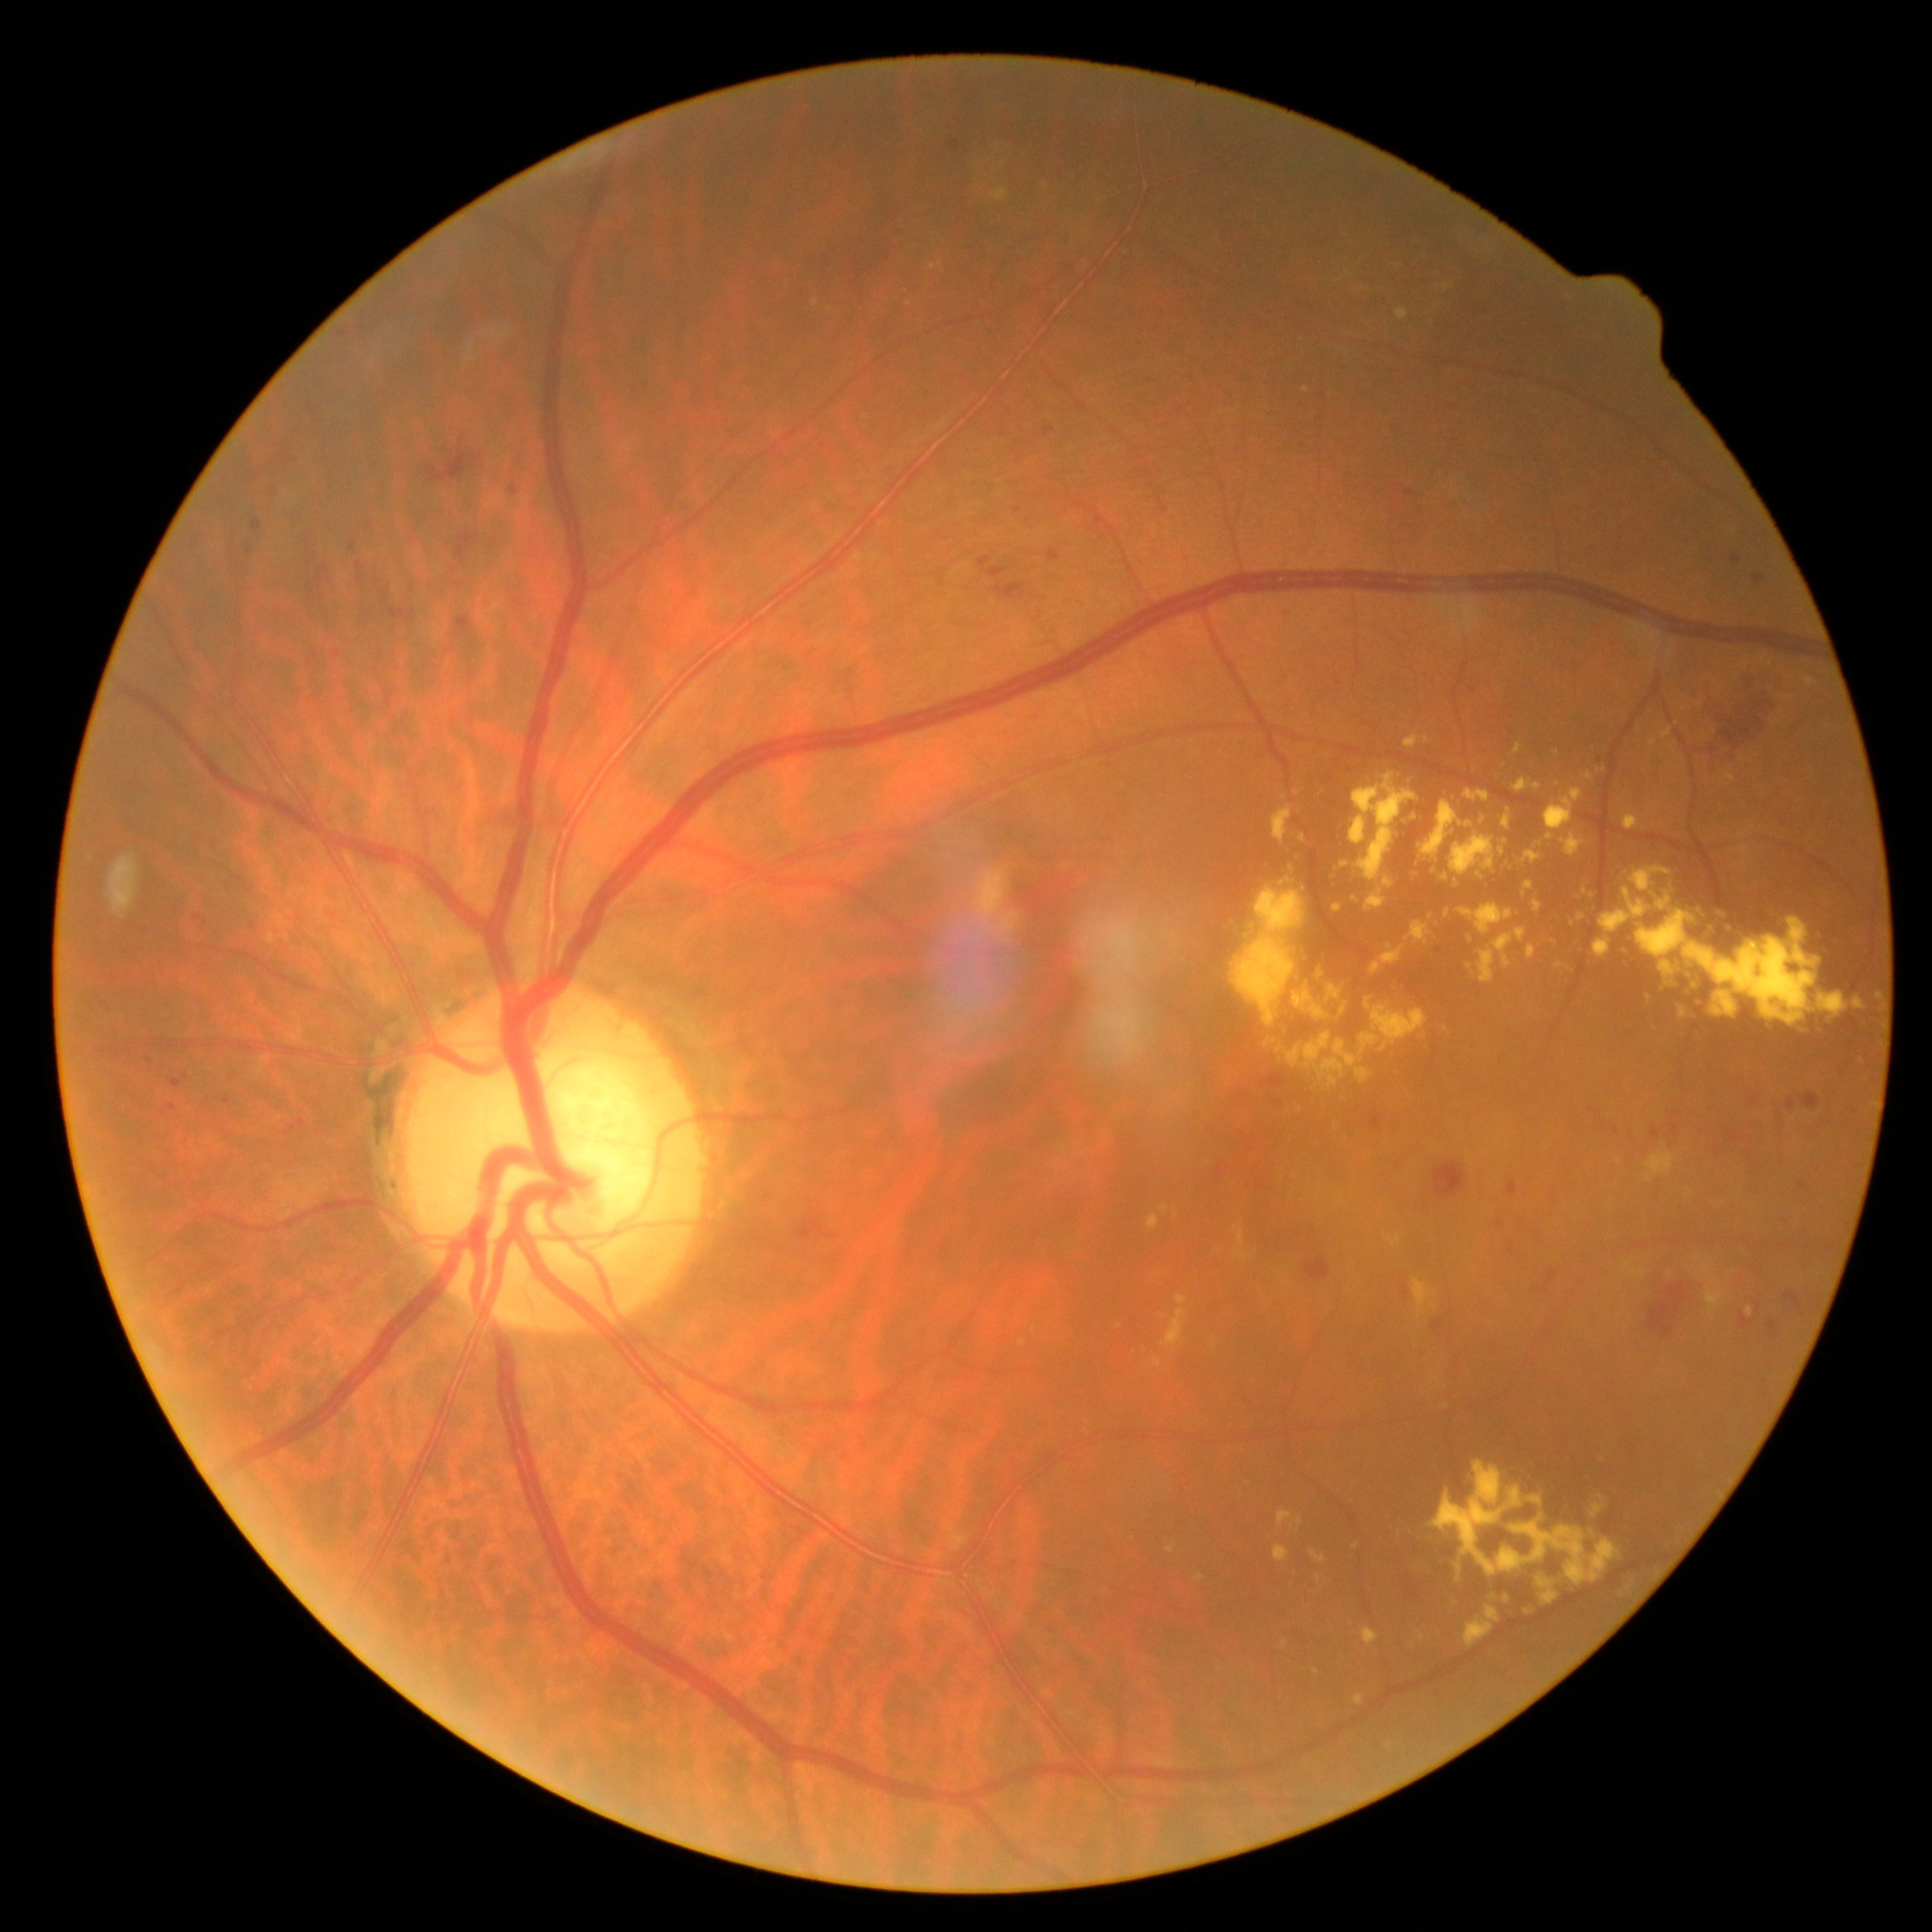 partial: true
dr_grade: 2
lesions:
  he:
    - <region>1731, 554, 1742, 563</region>
    - <region>456, 615, 473, 630</region>
    - <region>978, 556, 992, 567</region>
    - <region>1653, 1130, 1660, 1140</region>
    - <region>102, 1002, 111, 1010</region>
    - <region>1043, 423, 1055, 438</region>
    - <region>1798, 1182, 1805, 1190</region>
    - <region>992, 583, 1026, 600</region>
    - <region>1400, 1286, 1412, 1298</region>
    - <region>1541, 1273, 1556, 1294</region>
    - <region>119, 1168, 129, 1179</region>
    - <region>459, 439, 465, 447</region>
    - <region>427, 450, 470, 482</region>
  he_small_approx:
    - (1313; 1232)
    - (1350; 769)
    - (1439; 950)